2352 x 1568 pixels, CFP, 45° FOV
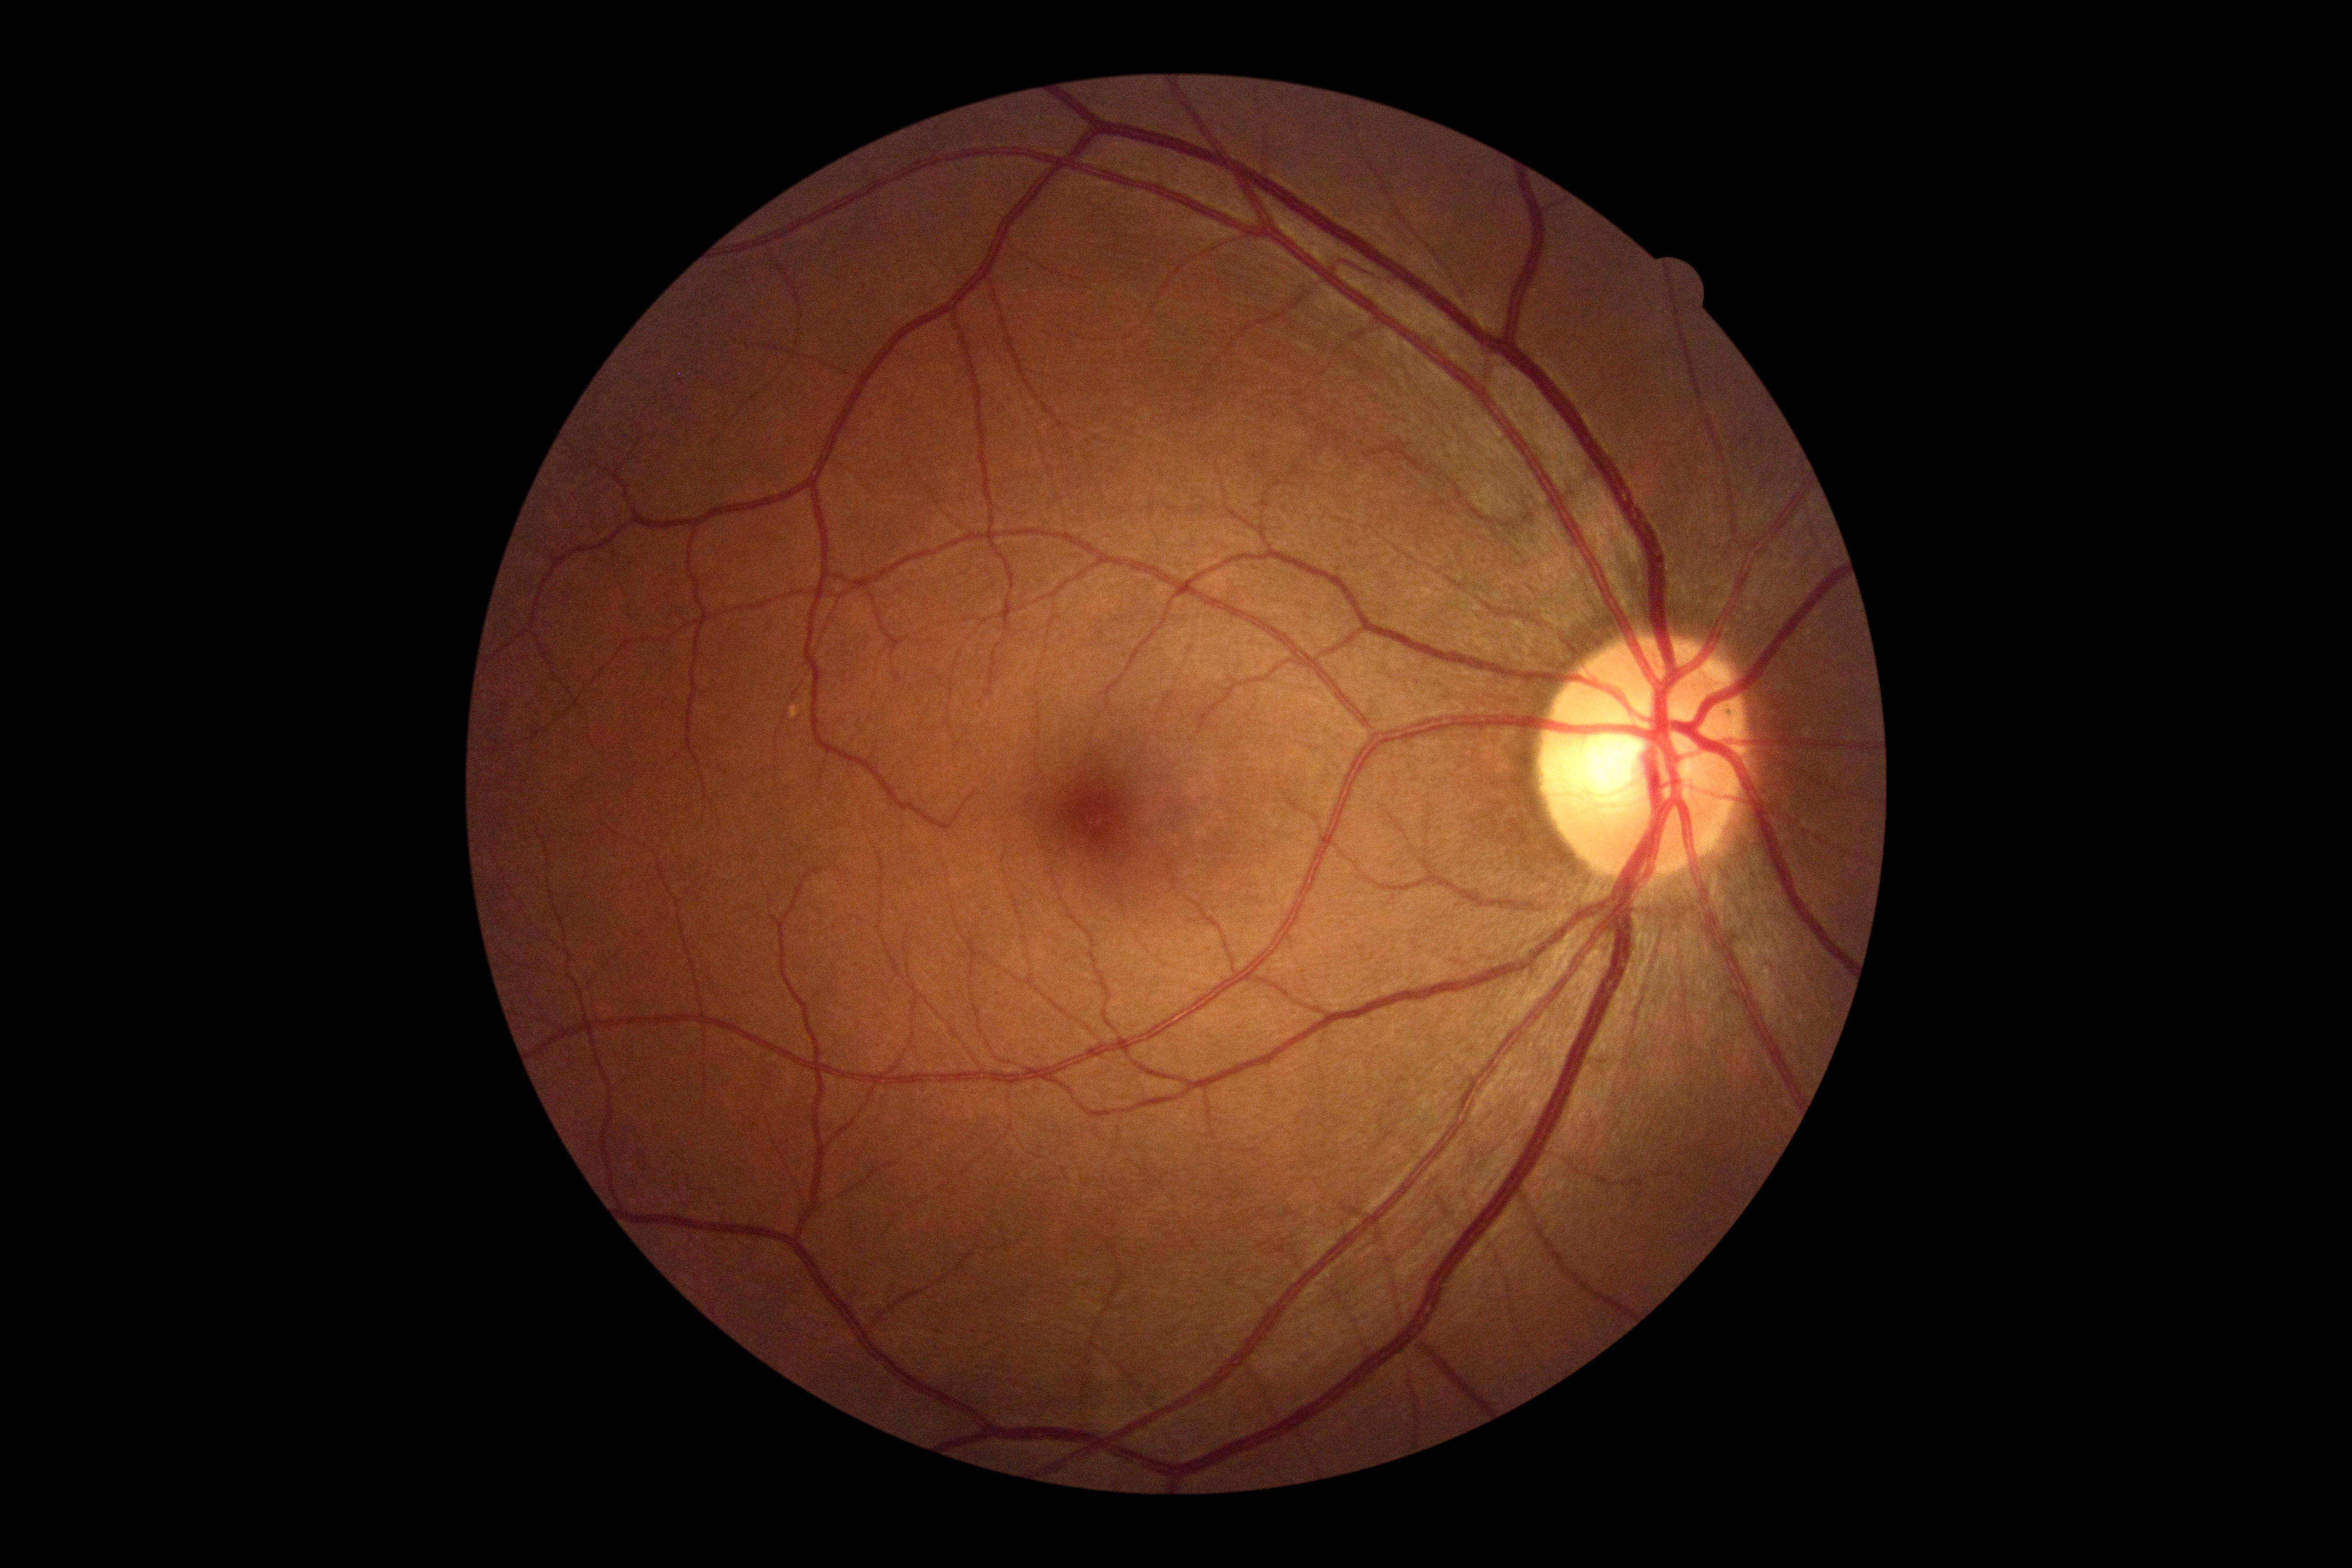 diabetic retinopathy severity: 0/4 — no visible signs of diabetic retinopathy, DR impression: no DR findings.